UWF retinal mosaic: 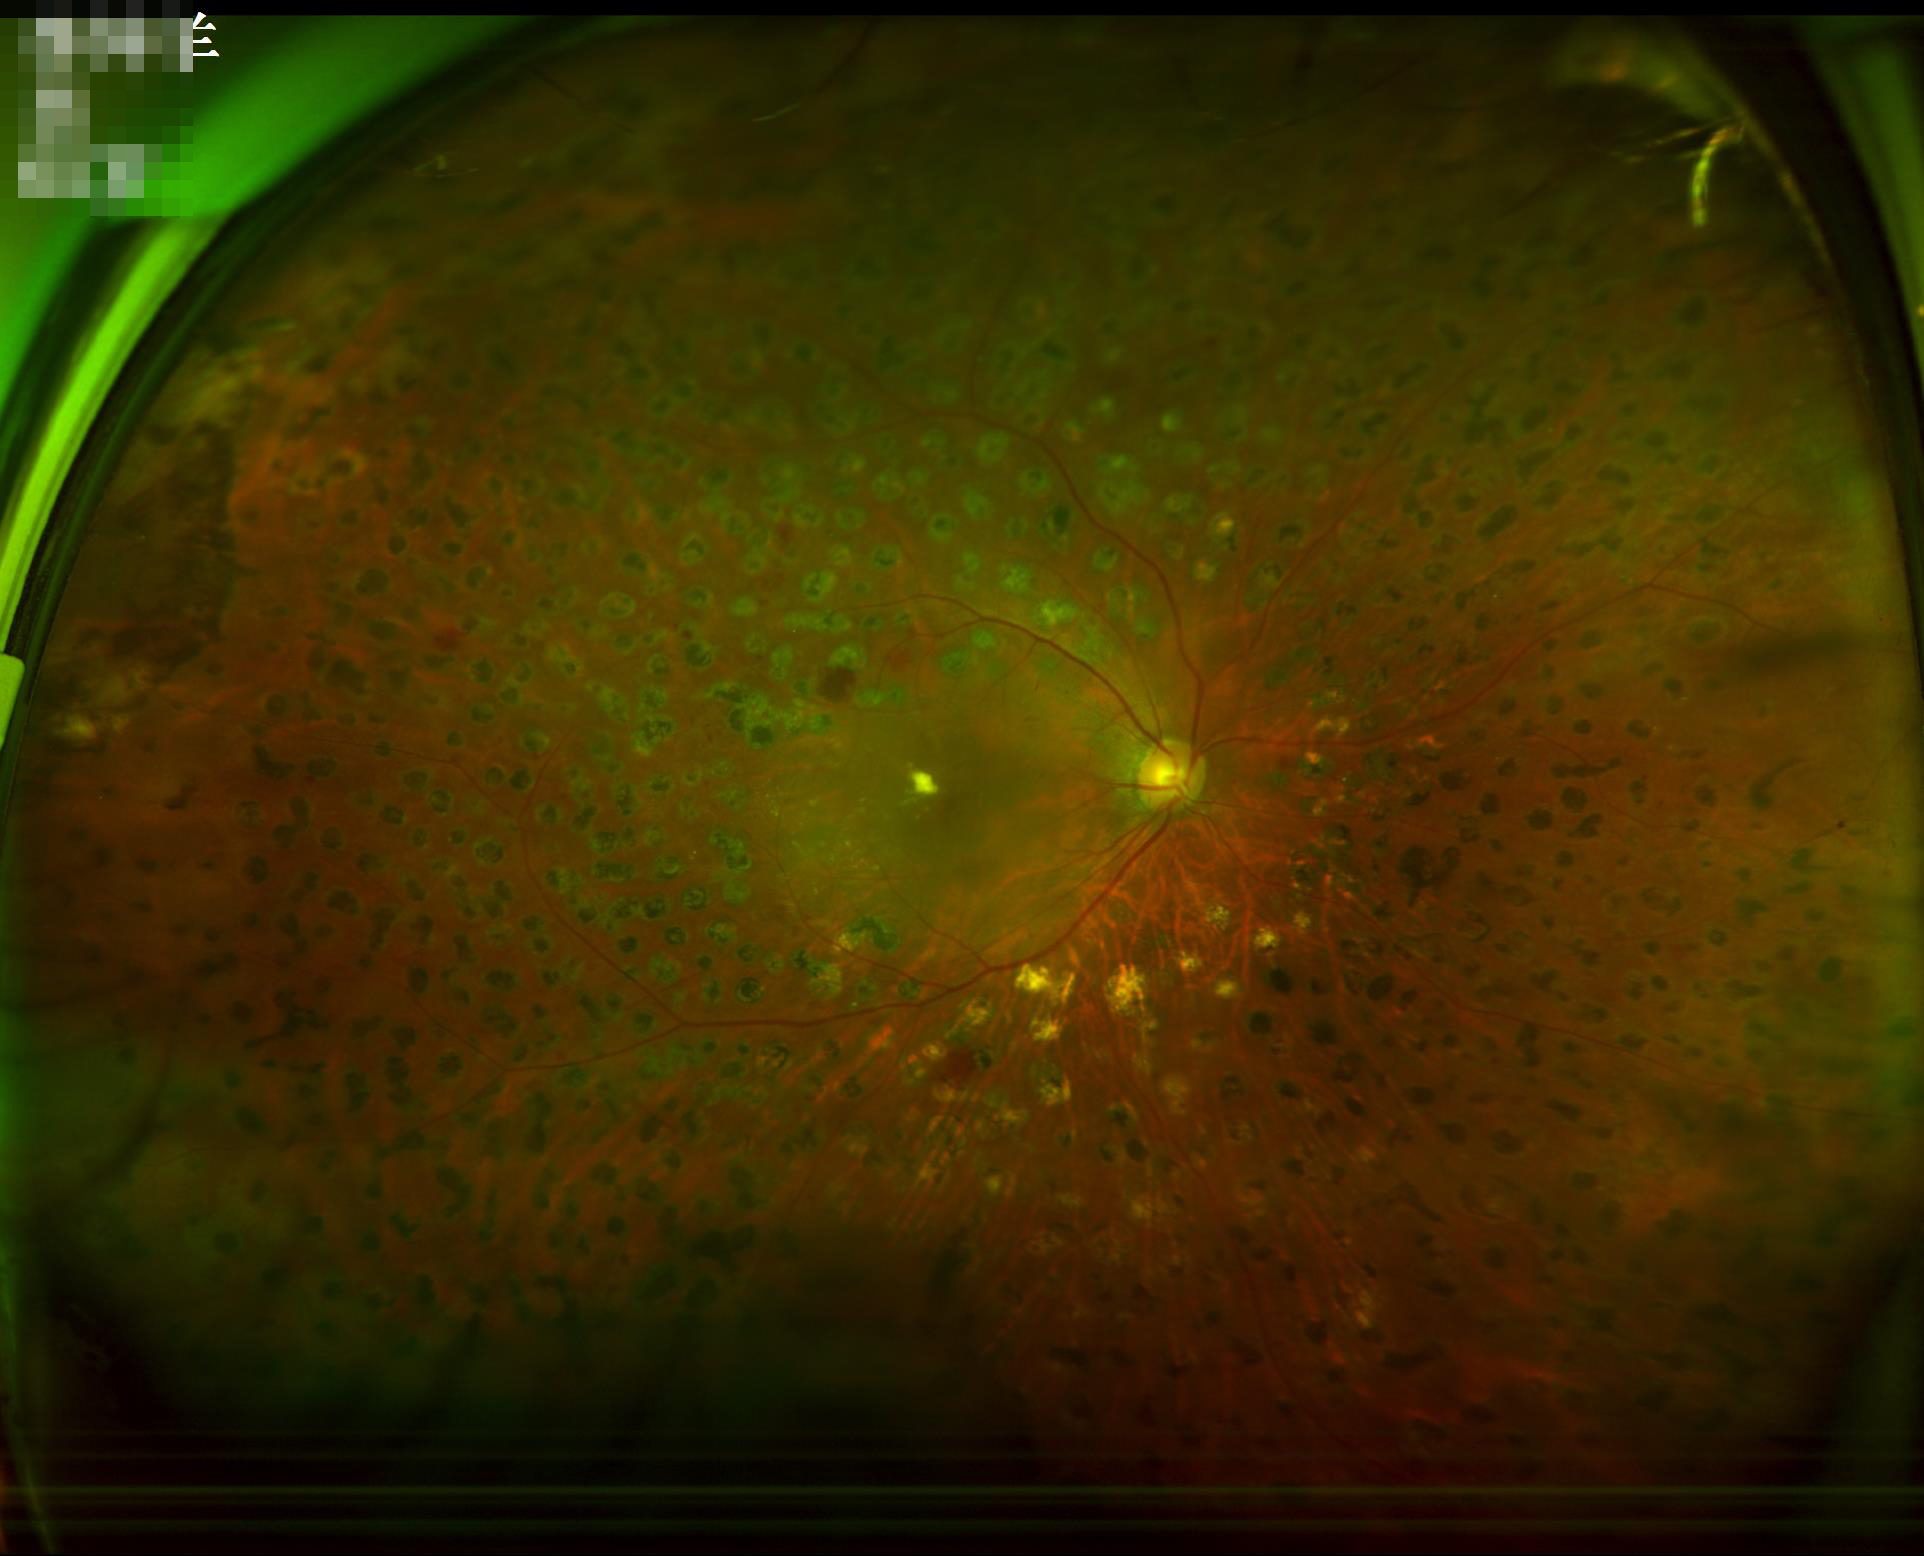

The image is clear.
Overall quality is good and the image is gradable.
Illumination and color balance are good.